Davis DR grading
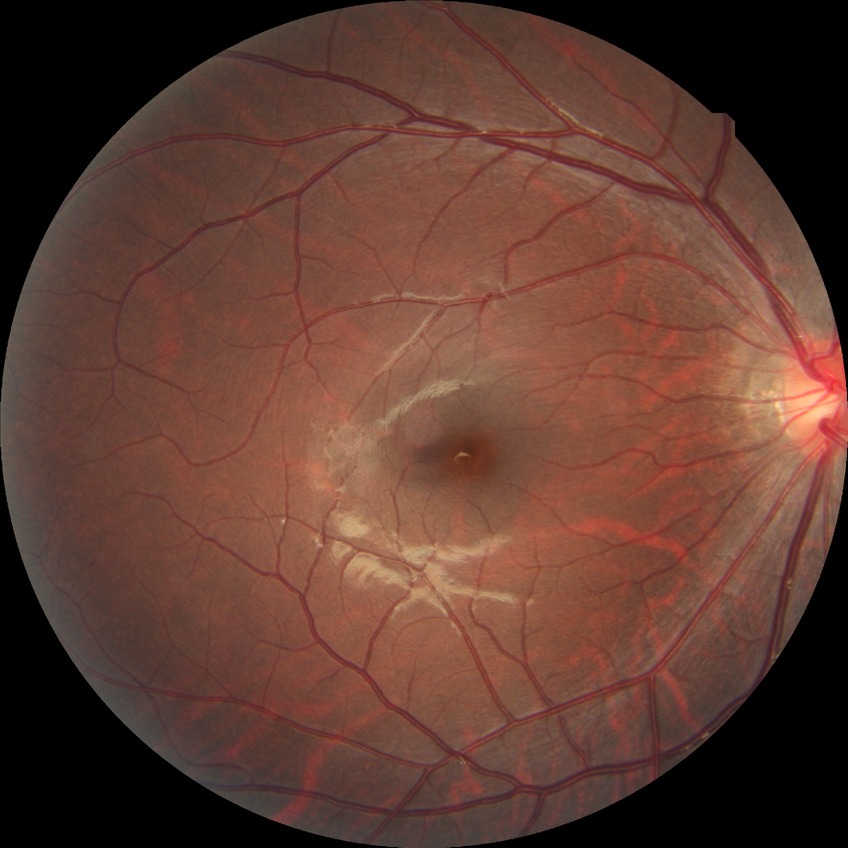 Diabetic retinopathy stage is no diabetic retinopathy.